Color fundus photograph — 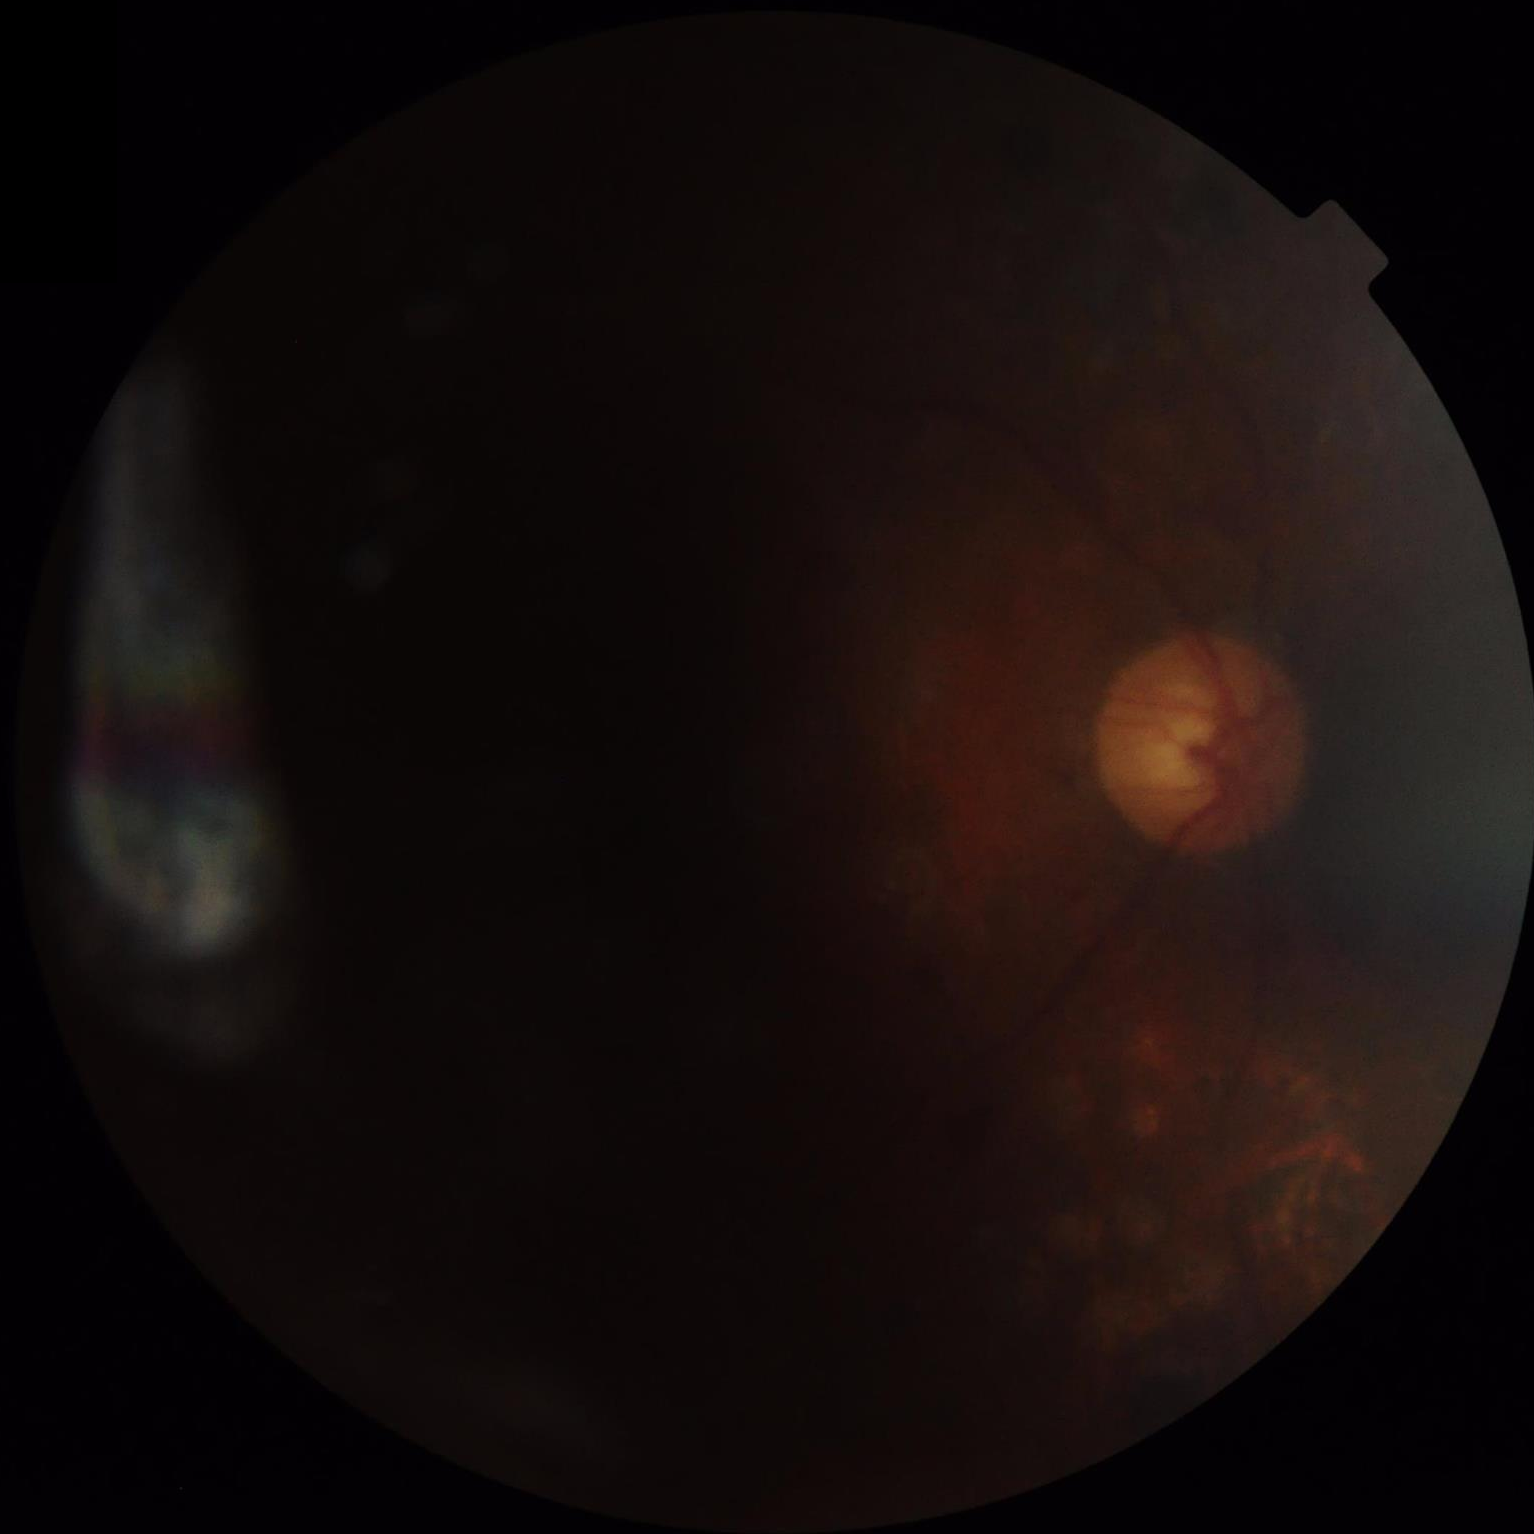
Illumination/color = over- or under-exposed | Contrast = low, vessels and details hard to distinguish | Clarity = noticeable blur in the optic disc, vessels, or background | Overall image quality = poor, ungradable.